640x480; wide-field contact fundus photograph of an infant — 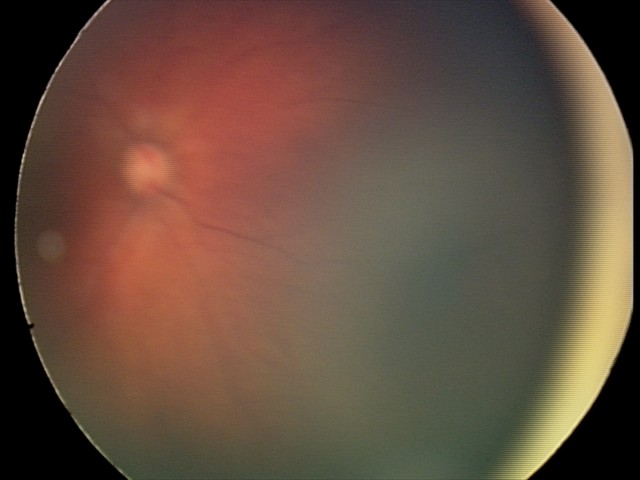
Screening series with retinal hemorrhages.